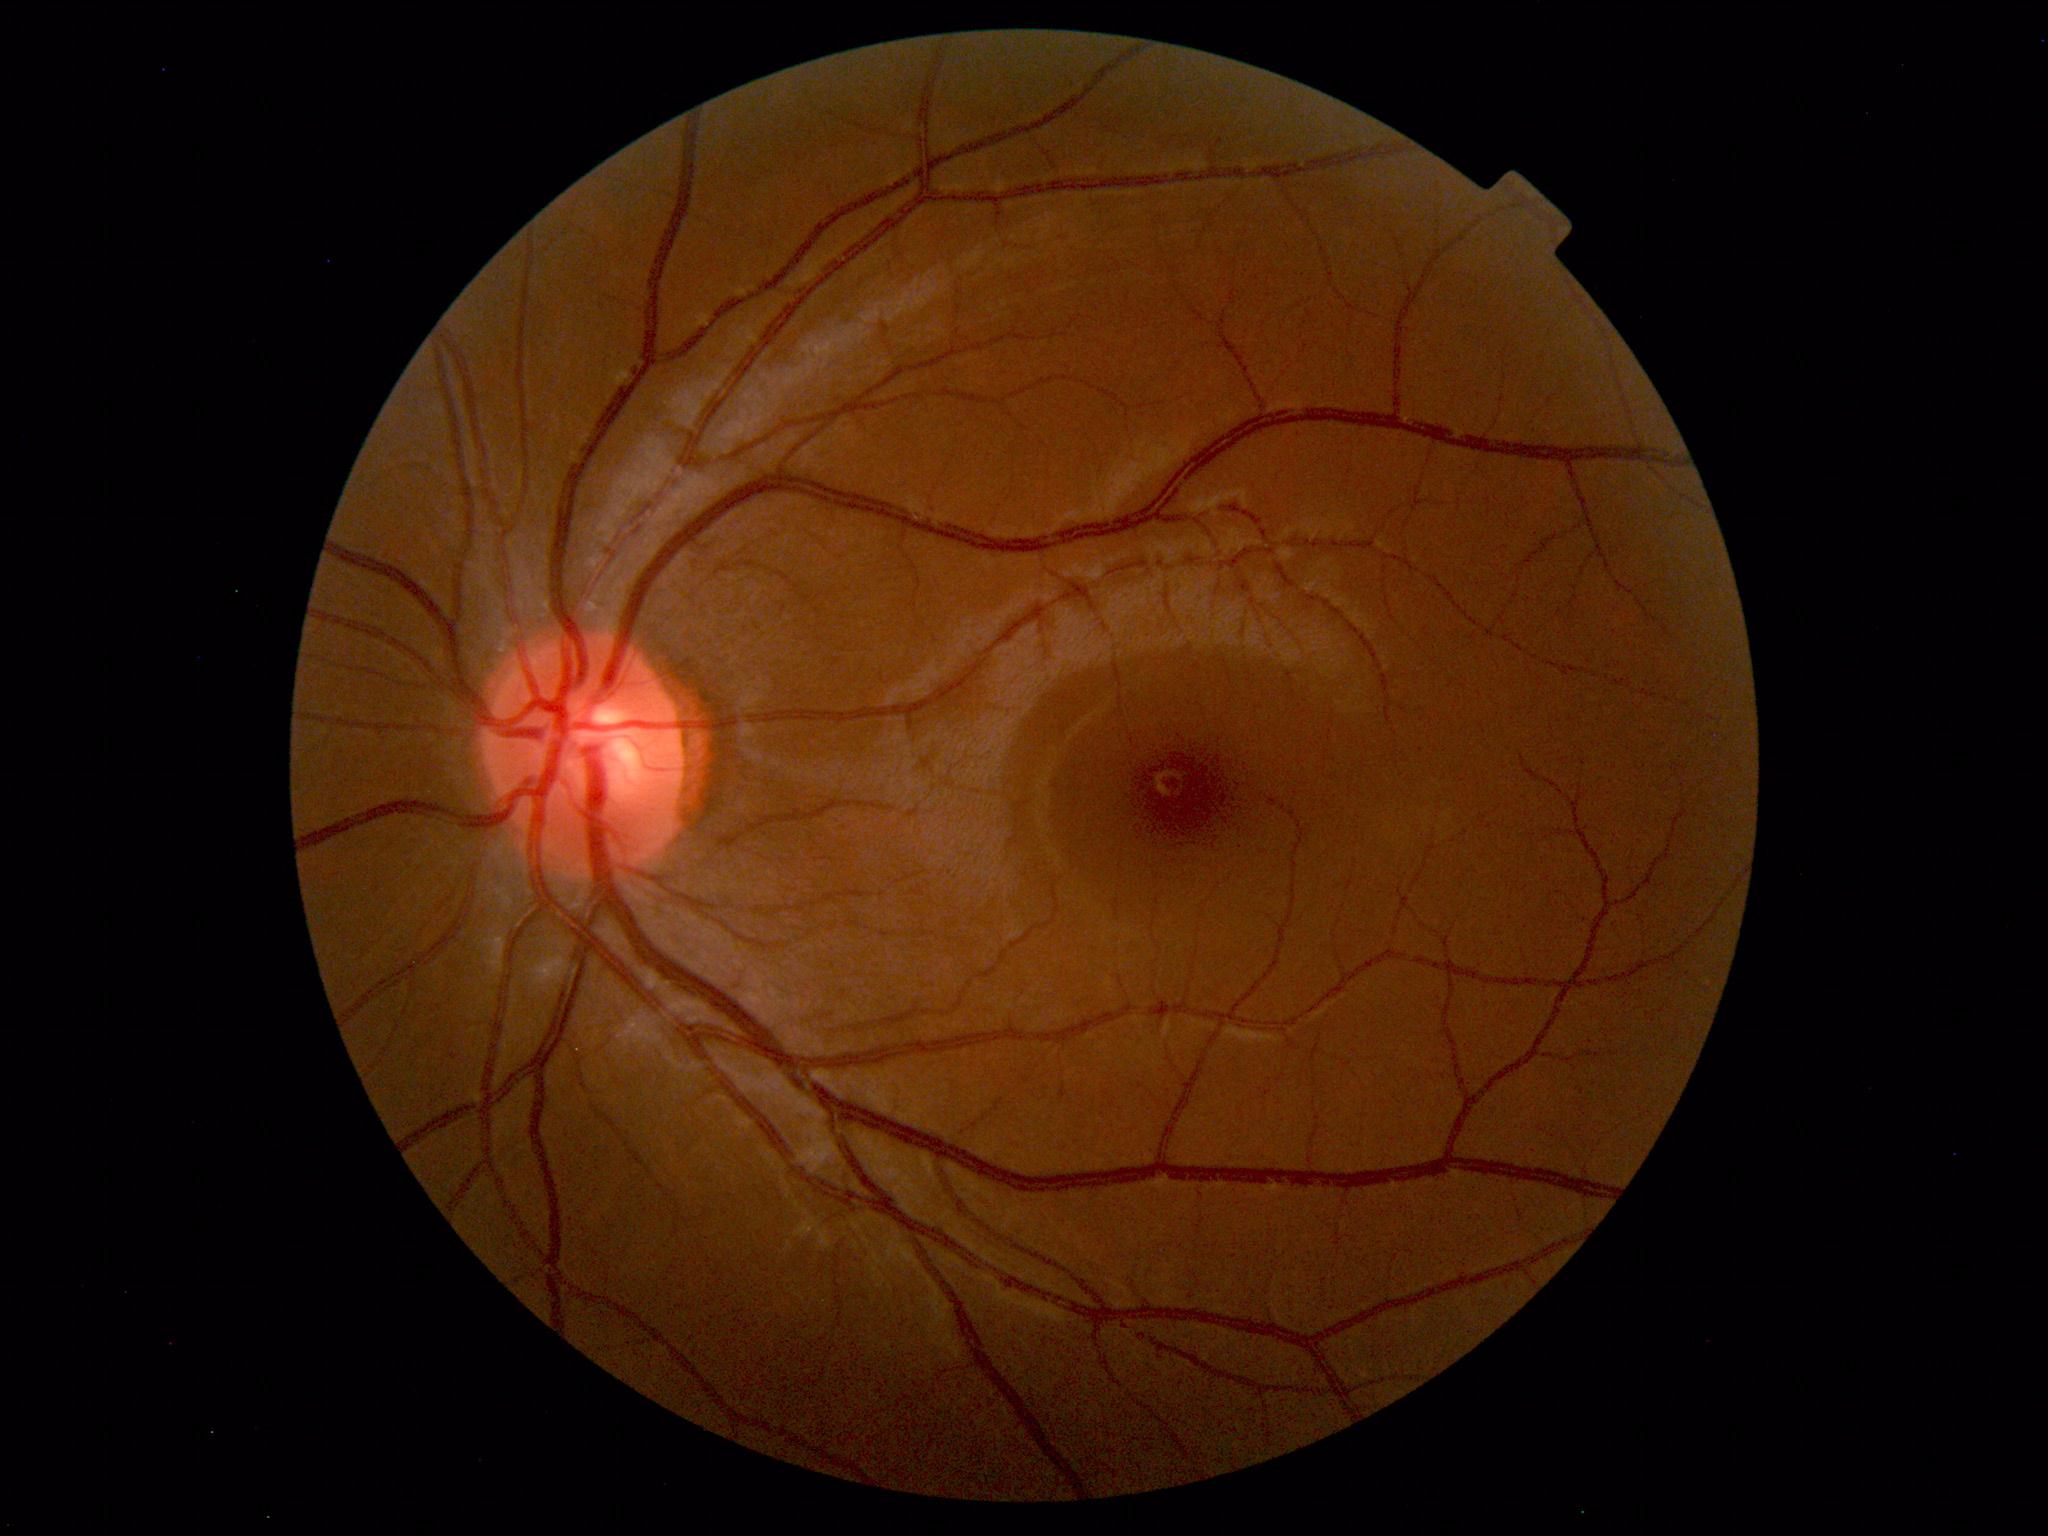

Diagnosis: normal.